45° field of view
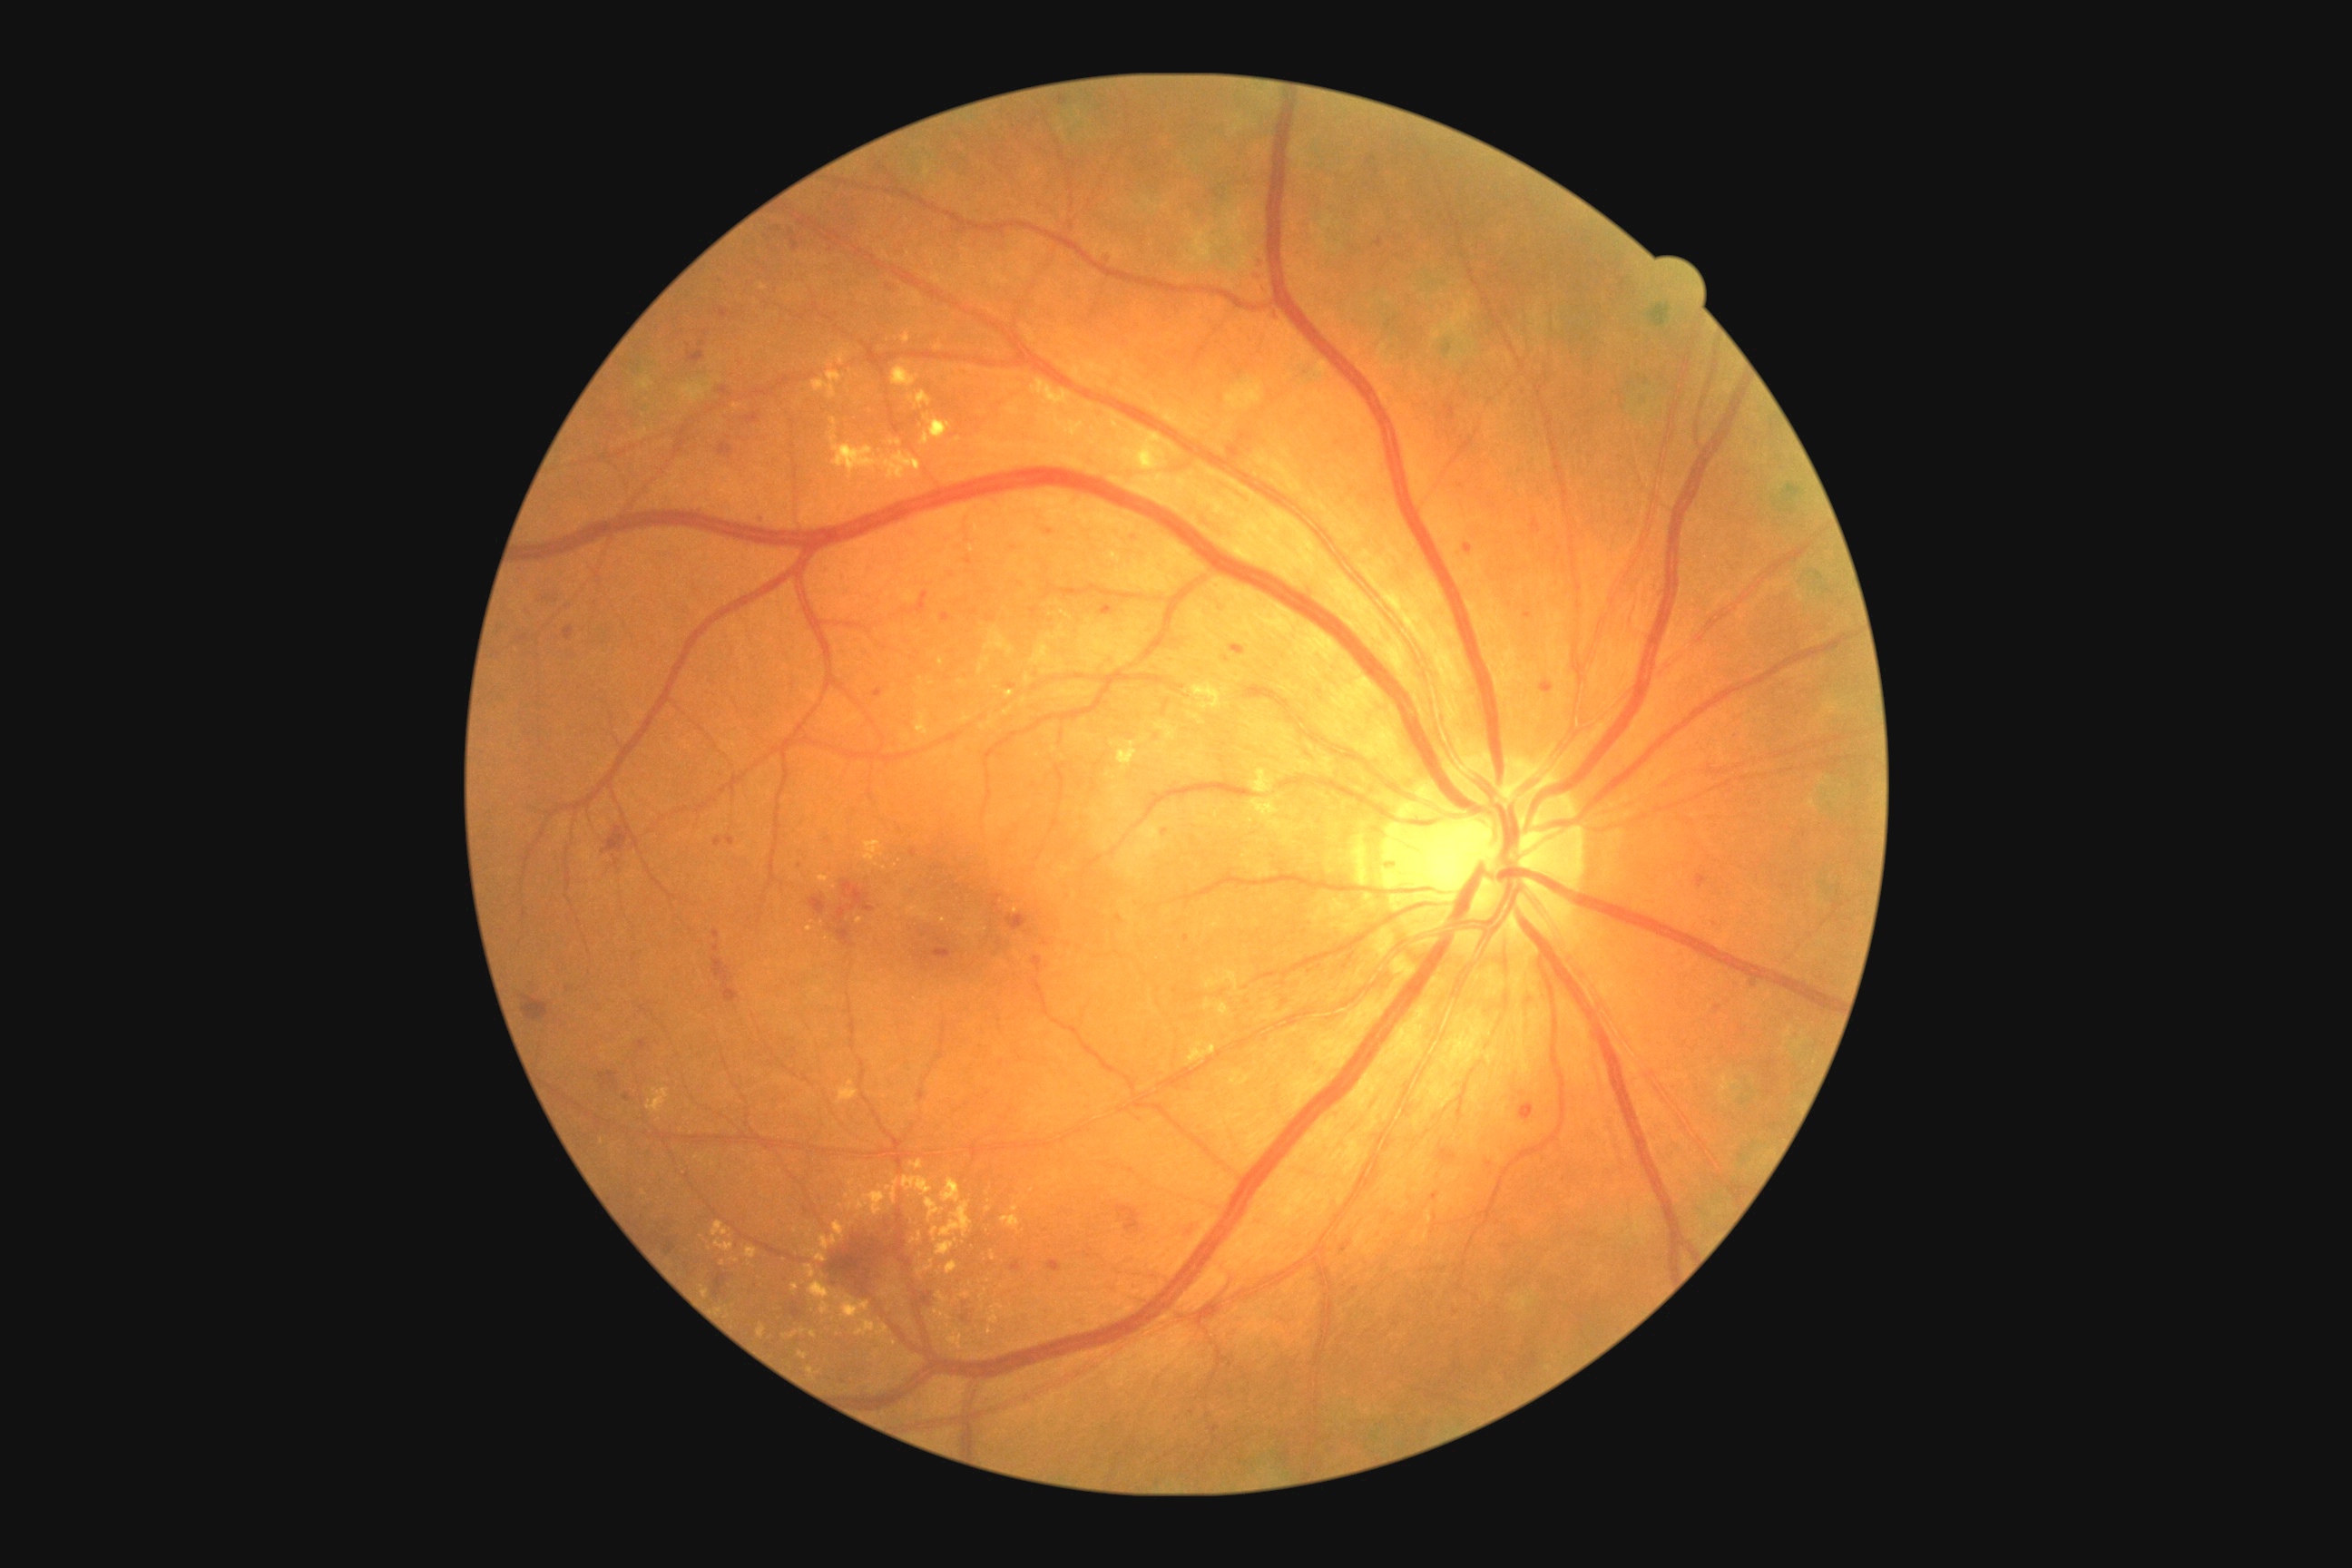
{"partial": true, "dr_grade": 2, "dr_grade_name": "moderate NPDR", "lesions": {"ex": [[936, 1309, 952, 1322], [847, 1191, 887, 1215], [887, 1181, 899, 1206], [888, 1286, 901, 1295], [819, 876, 828, 885], [830, 436, 921, 482], [903, 1177, 932, 1195], [948, 1329, 968, 1351], [845, 1190, 858, 1200], [1188, 1041, 1217, 1066], [783, 1329, 807, 1340], [807, 1367, 814, 1377]], "ex_small_approx": [[838, 1297], [1015, 1209], [836, 1294], [939, 348], [1016, 911], [1032, 1191], [826, 939]], "ma": [[714, 930, 721, 939], [625, 1093, 631, 1101], [1714, 1004, 1721, 1012], [1211, 1426, 1220, 1435], [1696, 874, 1709, 890], [1010, 1260, 1023, 1273], [874, 689, 883, 698], [1538, 681, 1553, 691], [1262, 280, 1266, 288], [720, 309, 730, 318], [1750, 981, 1759, 988], [1465, 545, 1473, 553]], "ma_small_approx": [[1119, 919], [924, 594], [827, 840], [1108, 260], [1455, 1313], [1277, 316]], "se": null, "he": [[808, 896, 827, 916], [825, 1220, 894, 1304], [1006, 914, 1030, 932], [665, 1239, 678, 1255], [712, 957, 738, 1004], [1181, 1220, 1206, 1239], [600, 1072, 618, 1088], [932, 948, 954, 959], [1115, 1206, 1142, 1235], [1230, 645, 1246, 656], [721, 387, 730, 395], [540, 589, 560, 603]]}}